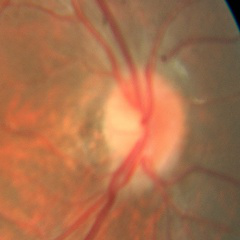 Optic disc appearance consistent with no glaucomatous findings.